1240 x 1240 pixels; wide-field fundus photograph from neonatal ROP screening
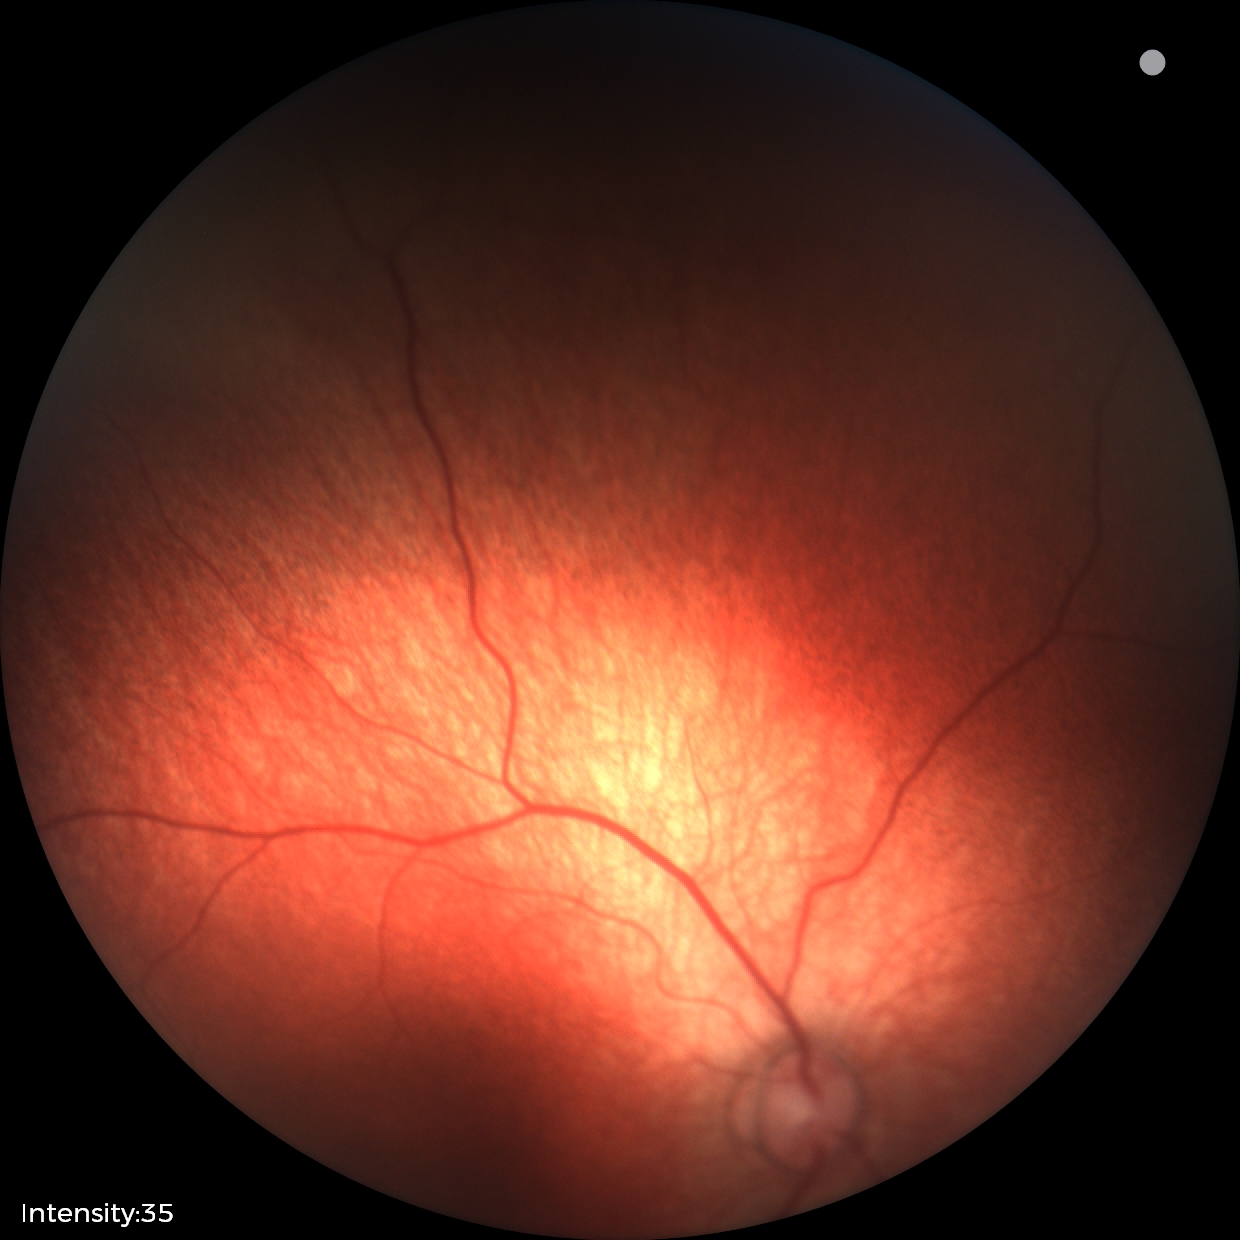

Physiological retinal appearance for postconceptual age.